Without pupil dilation · image size 848x848 · color fundus photograph · NIDEK AFC-230 fundus camera — 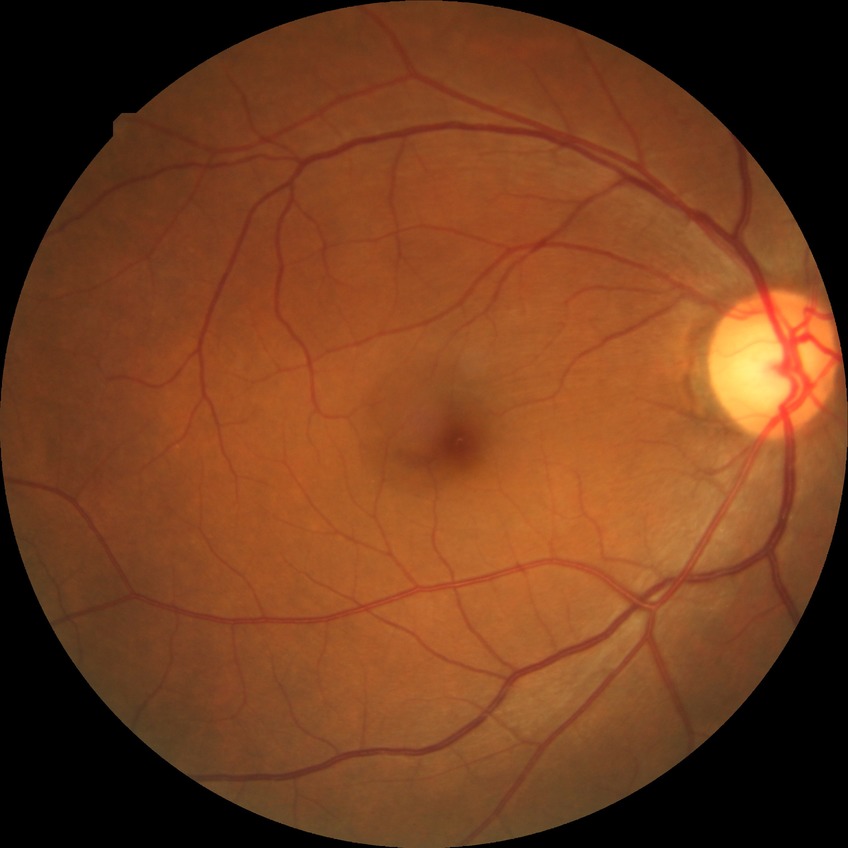

diabetic retinopathy (DR) = NDR (no diabetic retinopathy).